2352 by 1568 pixels: 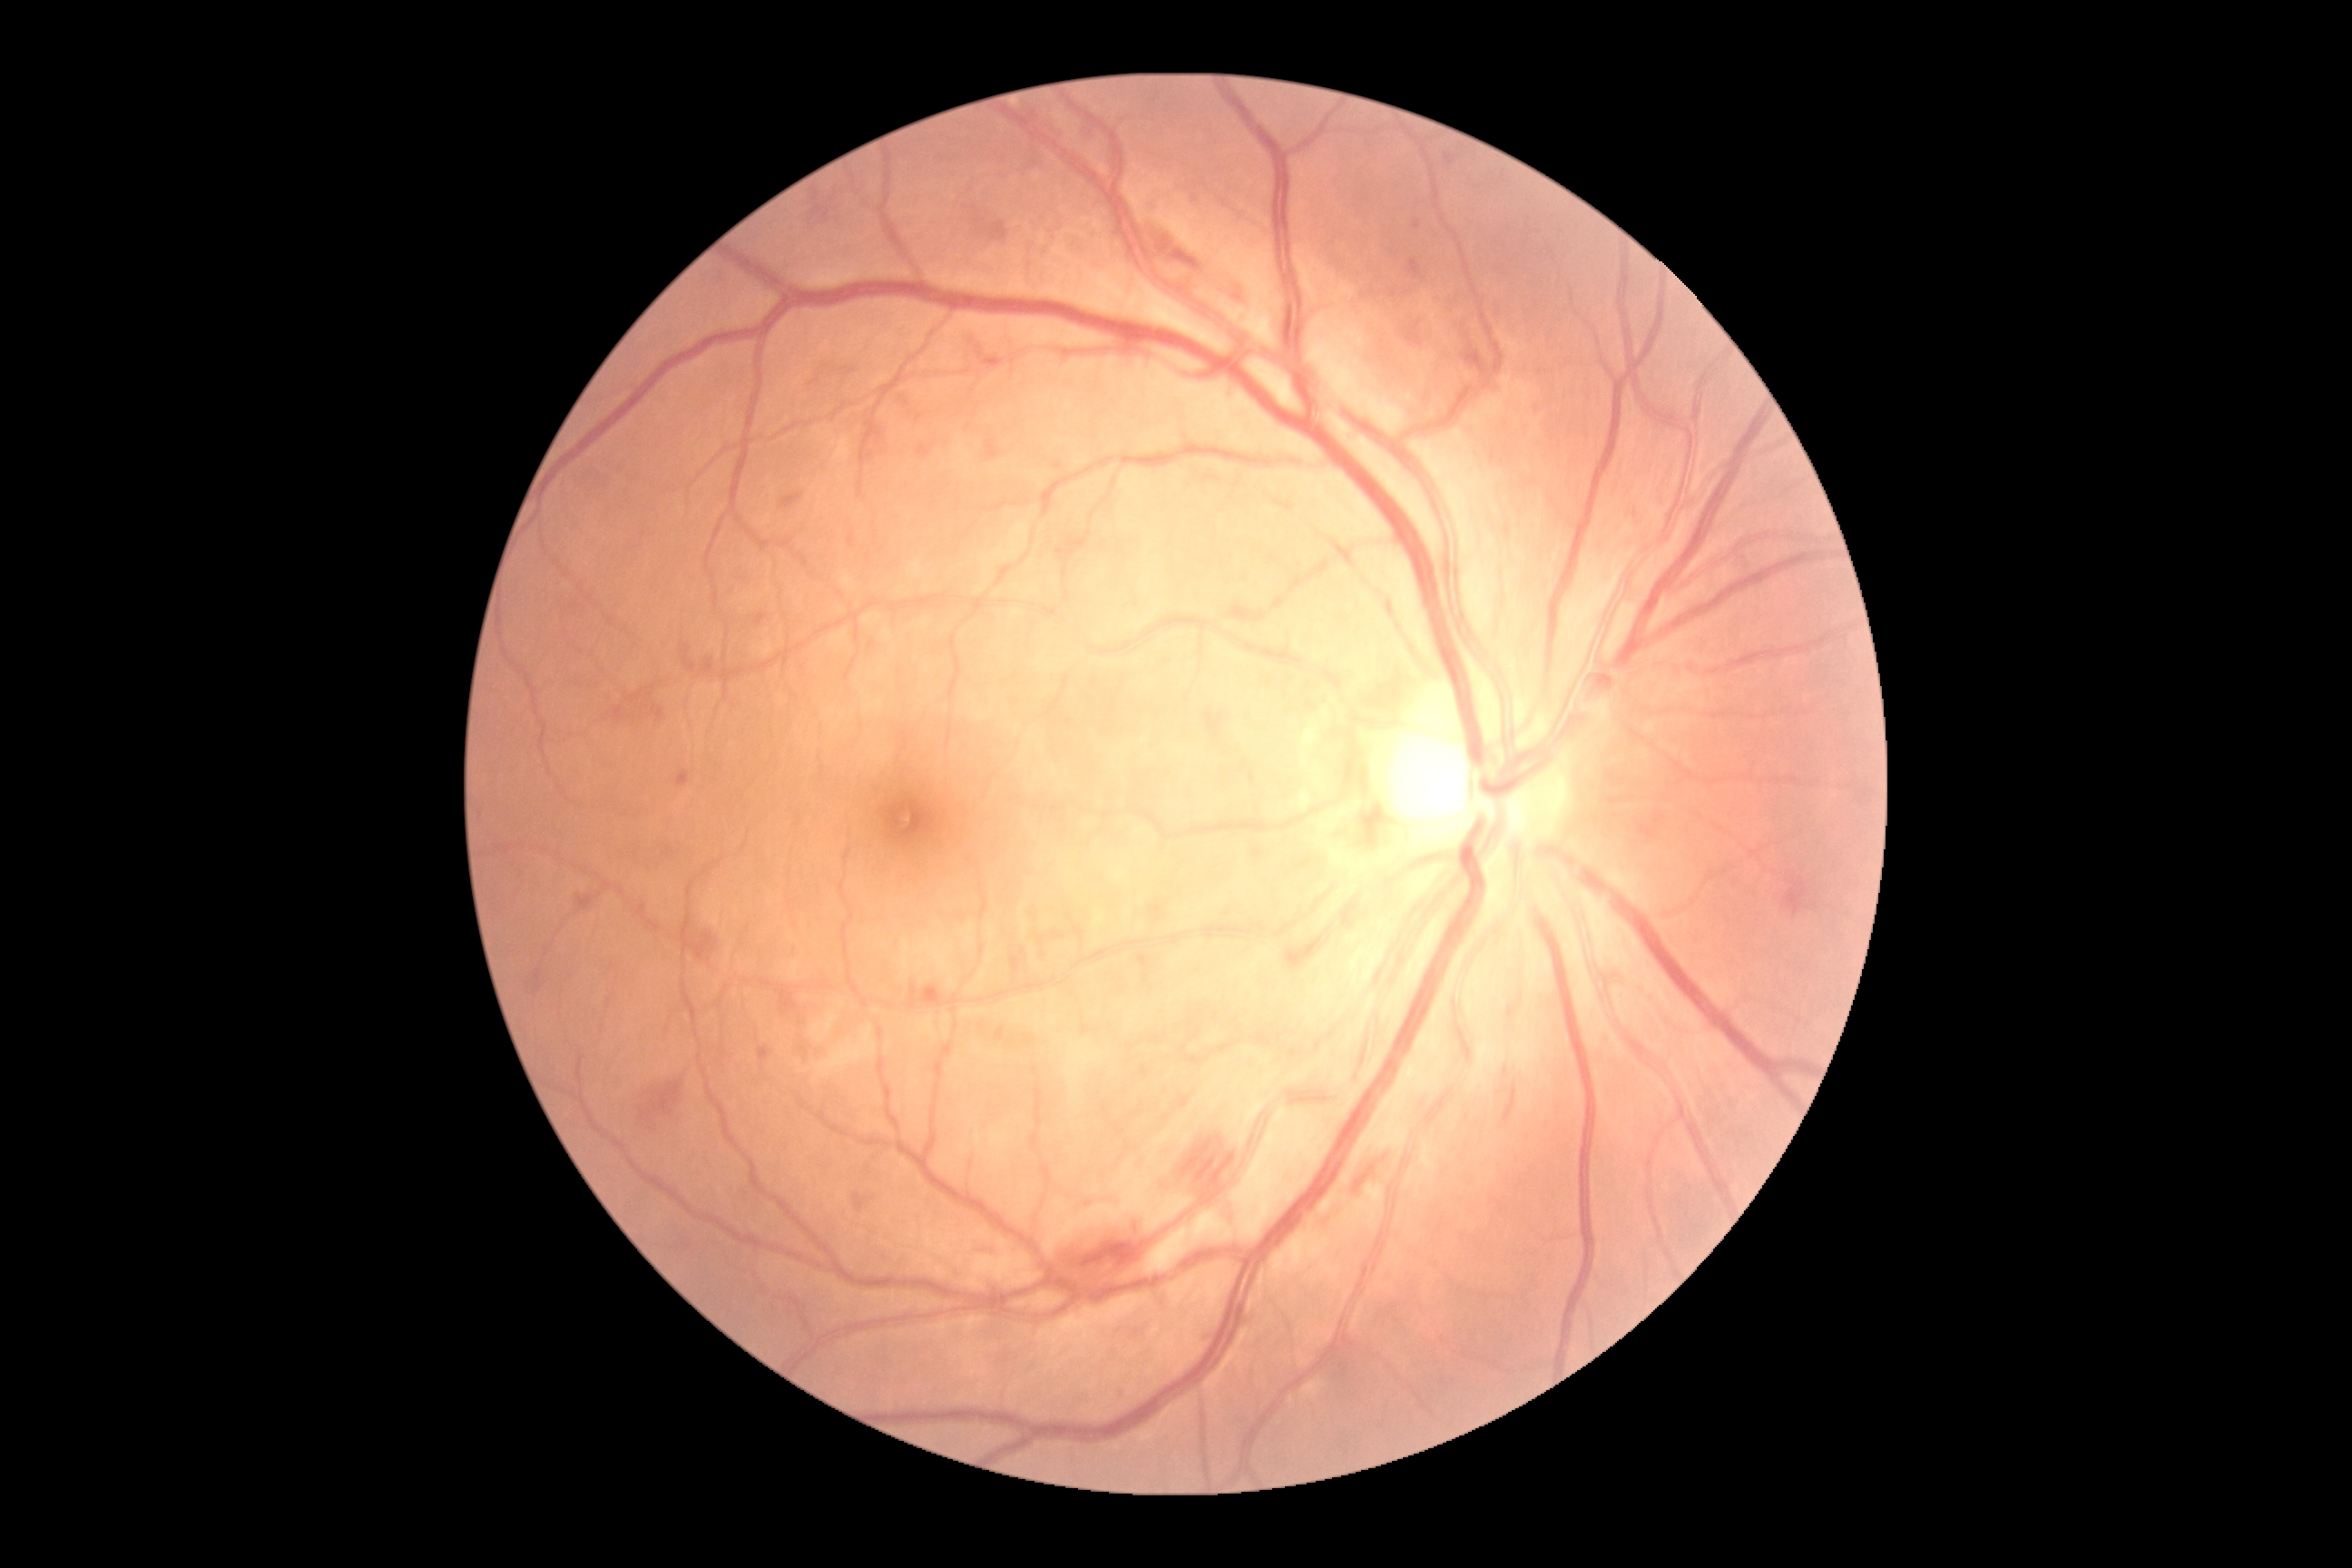
DR stage: moderate NPDR (grade 2). DR class: non-proliferative diabetic retinopathy.